Pediatric wide-field fundus photograph; 1440x1080; captured with the Natus RetCam Envision (130° field of view) — 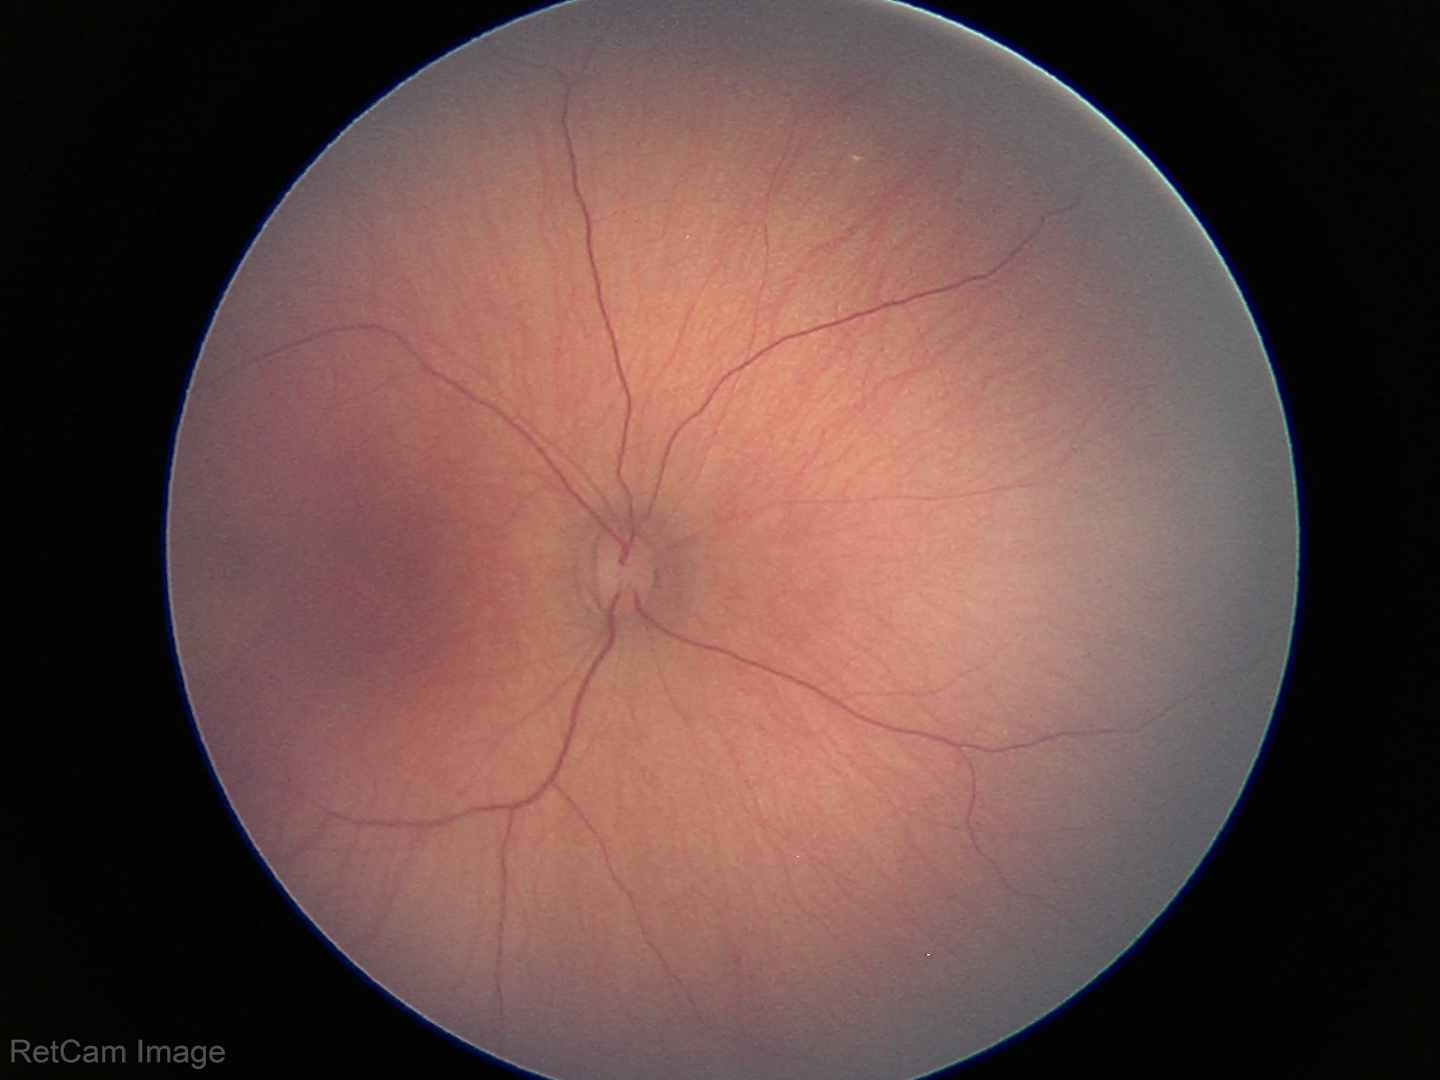
Physiological retinal appearance for postconceptual age.